45-degree field of view — 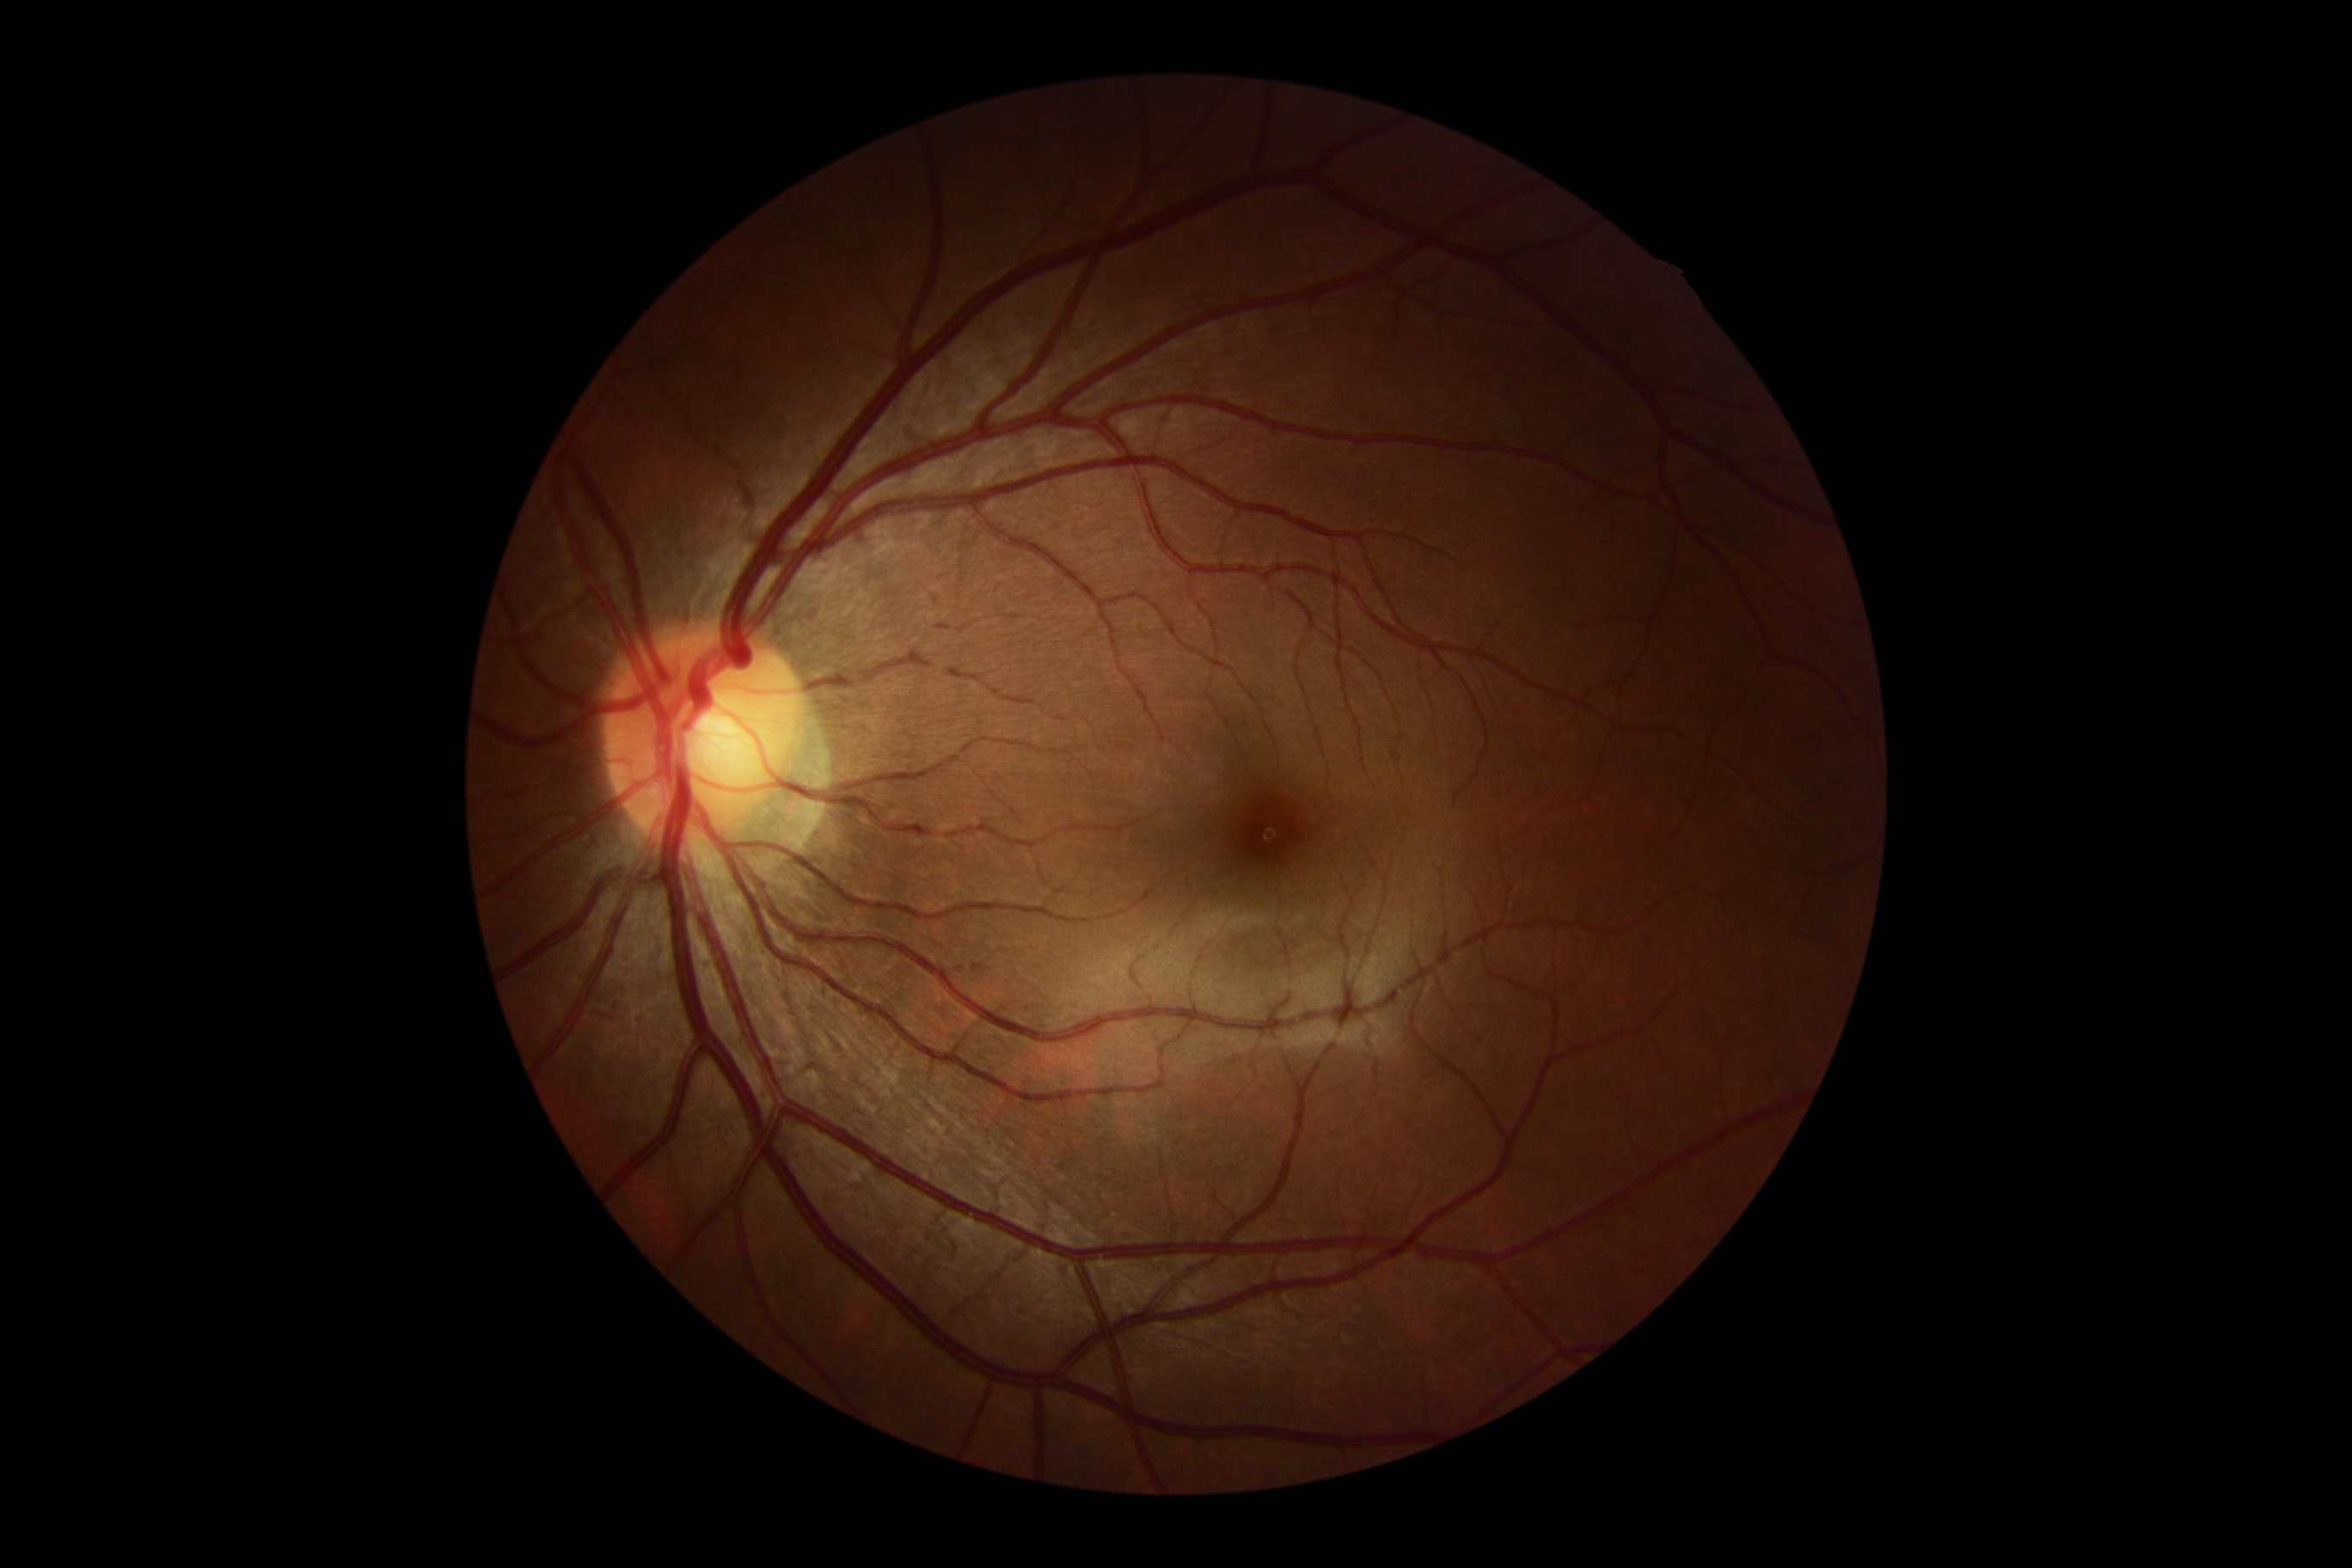 • DR stage: grade 0 (no apparent retinopathy)
• DR impression: no signs of DR